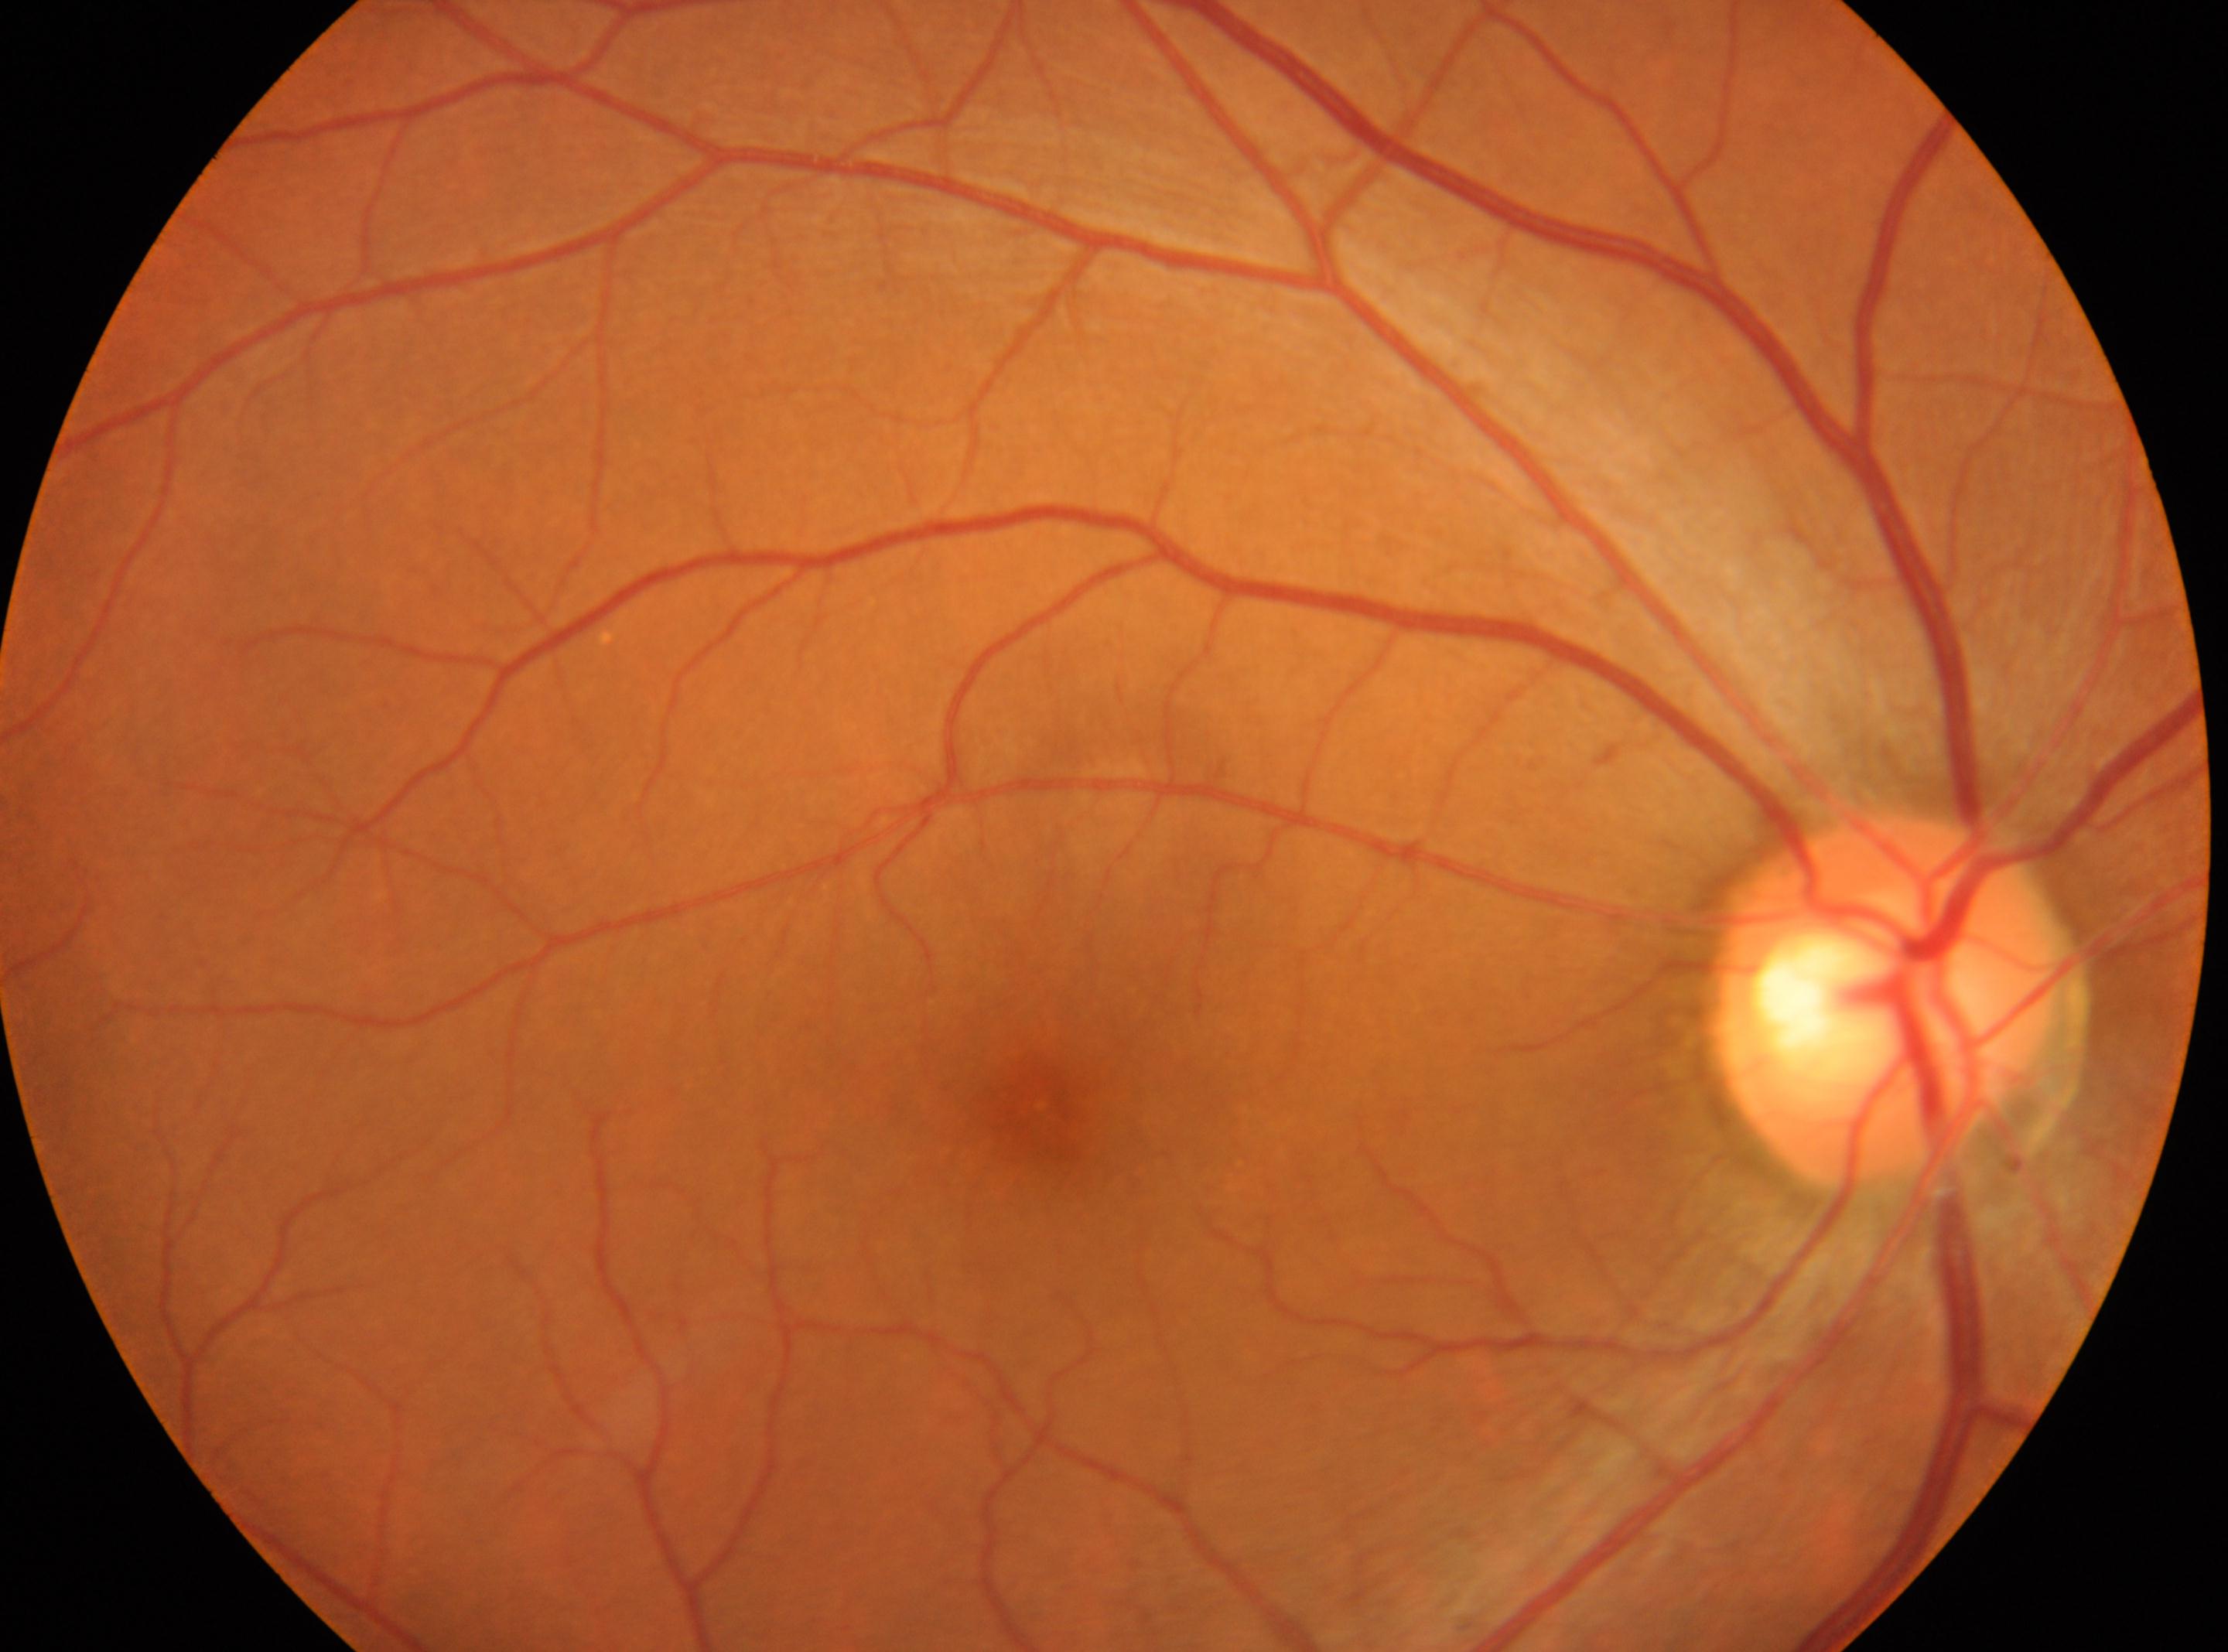 DR grade: 0
fovea centralis: (1038, 1106)
optic disc: (1884, 999)
right eye